Pediatric wide-field fundus photograph. Captured with the Phoenix ICON (100° field of view): 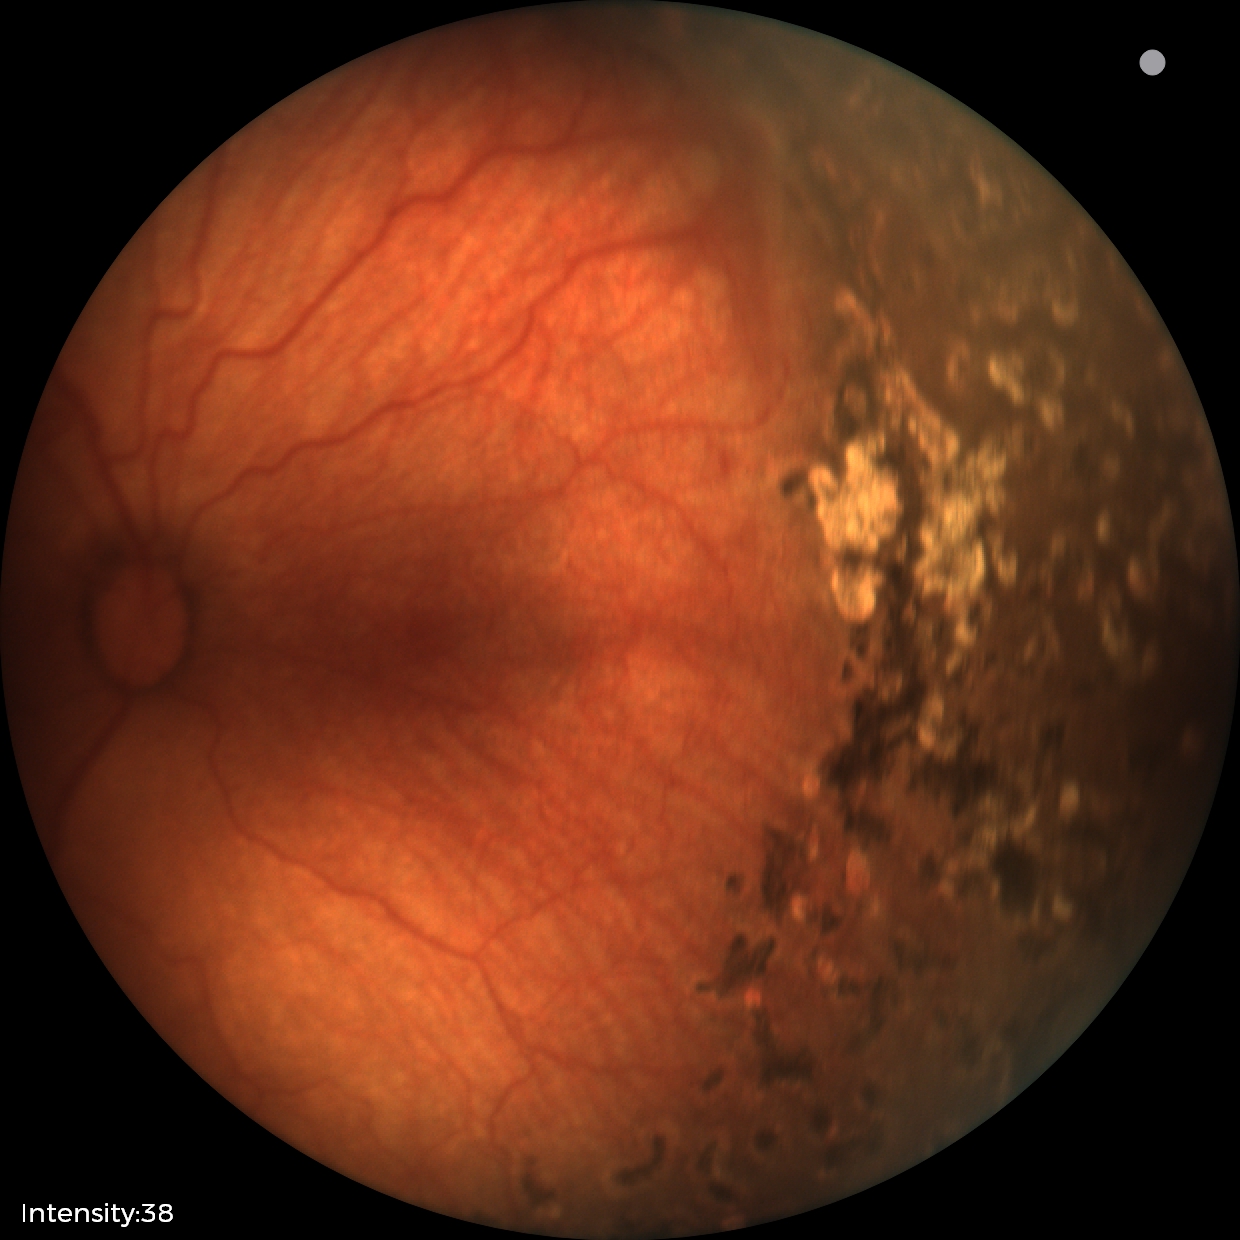

No plus disease. Series diagnosed as status post retinopathy of prematurity.